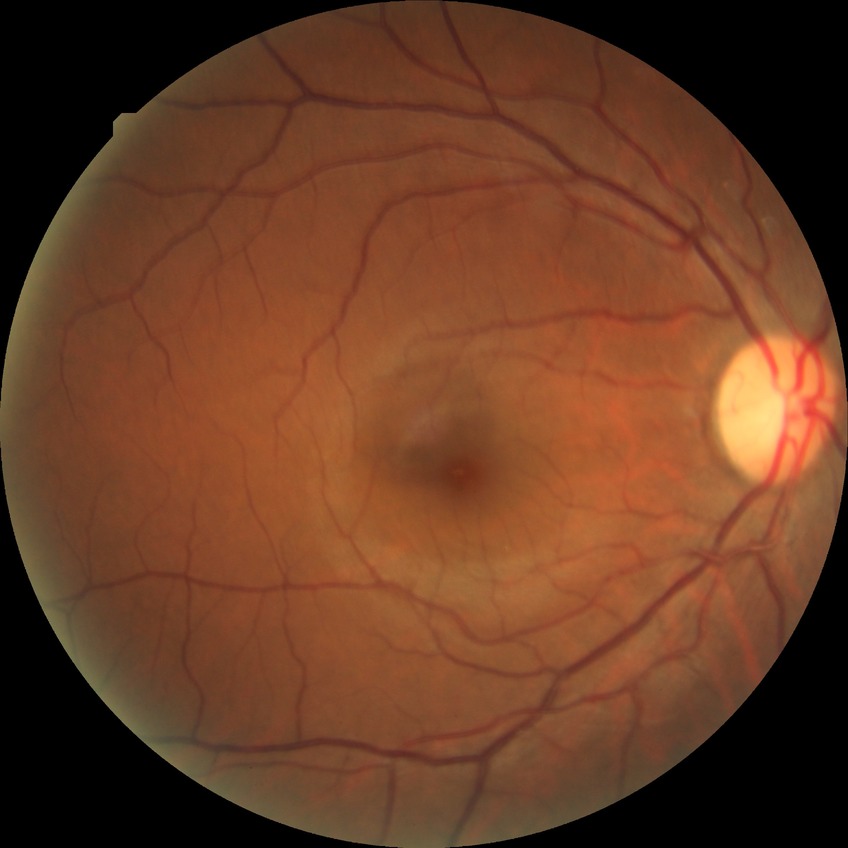
Davis grading: no diabetic retinopathy.